848x848px · 45 degree fundus photograph · diabetic retinopathy graded by the modified Davis classification · nonmydriatic · fundus photo.
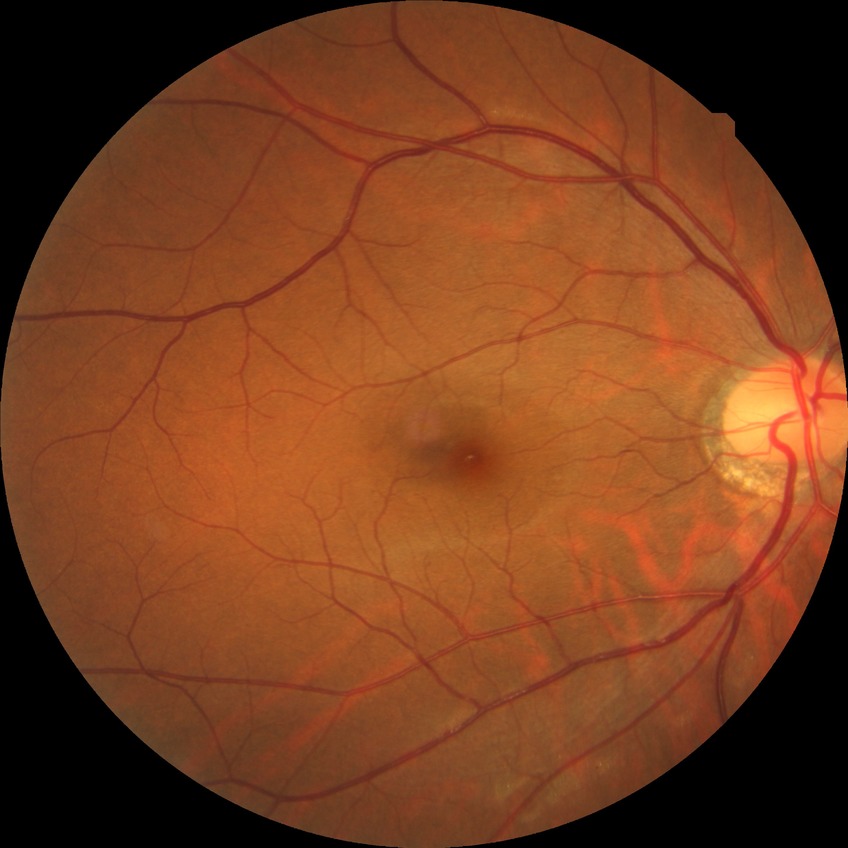

Retinopathy grade is no diabetic retinopathy.